Color fundus photograph; 2352x1568px.
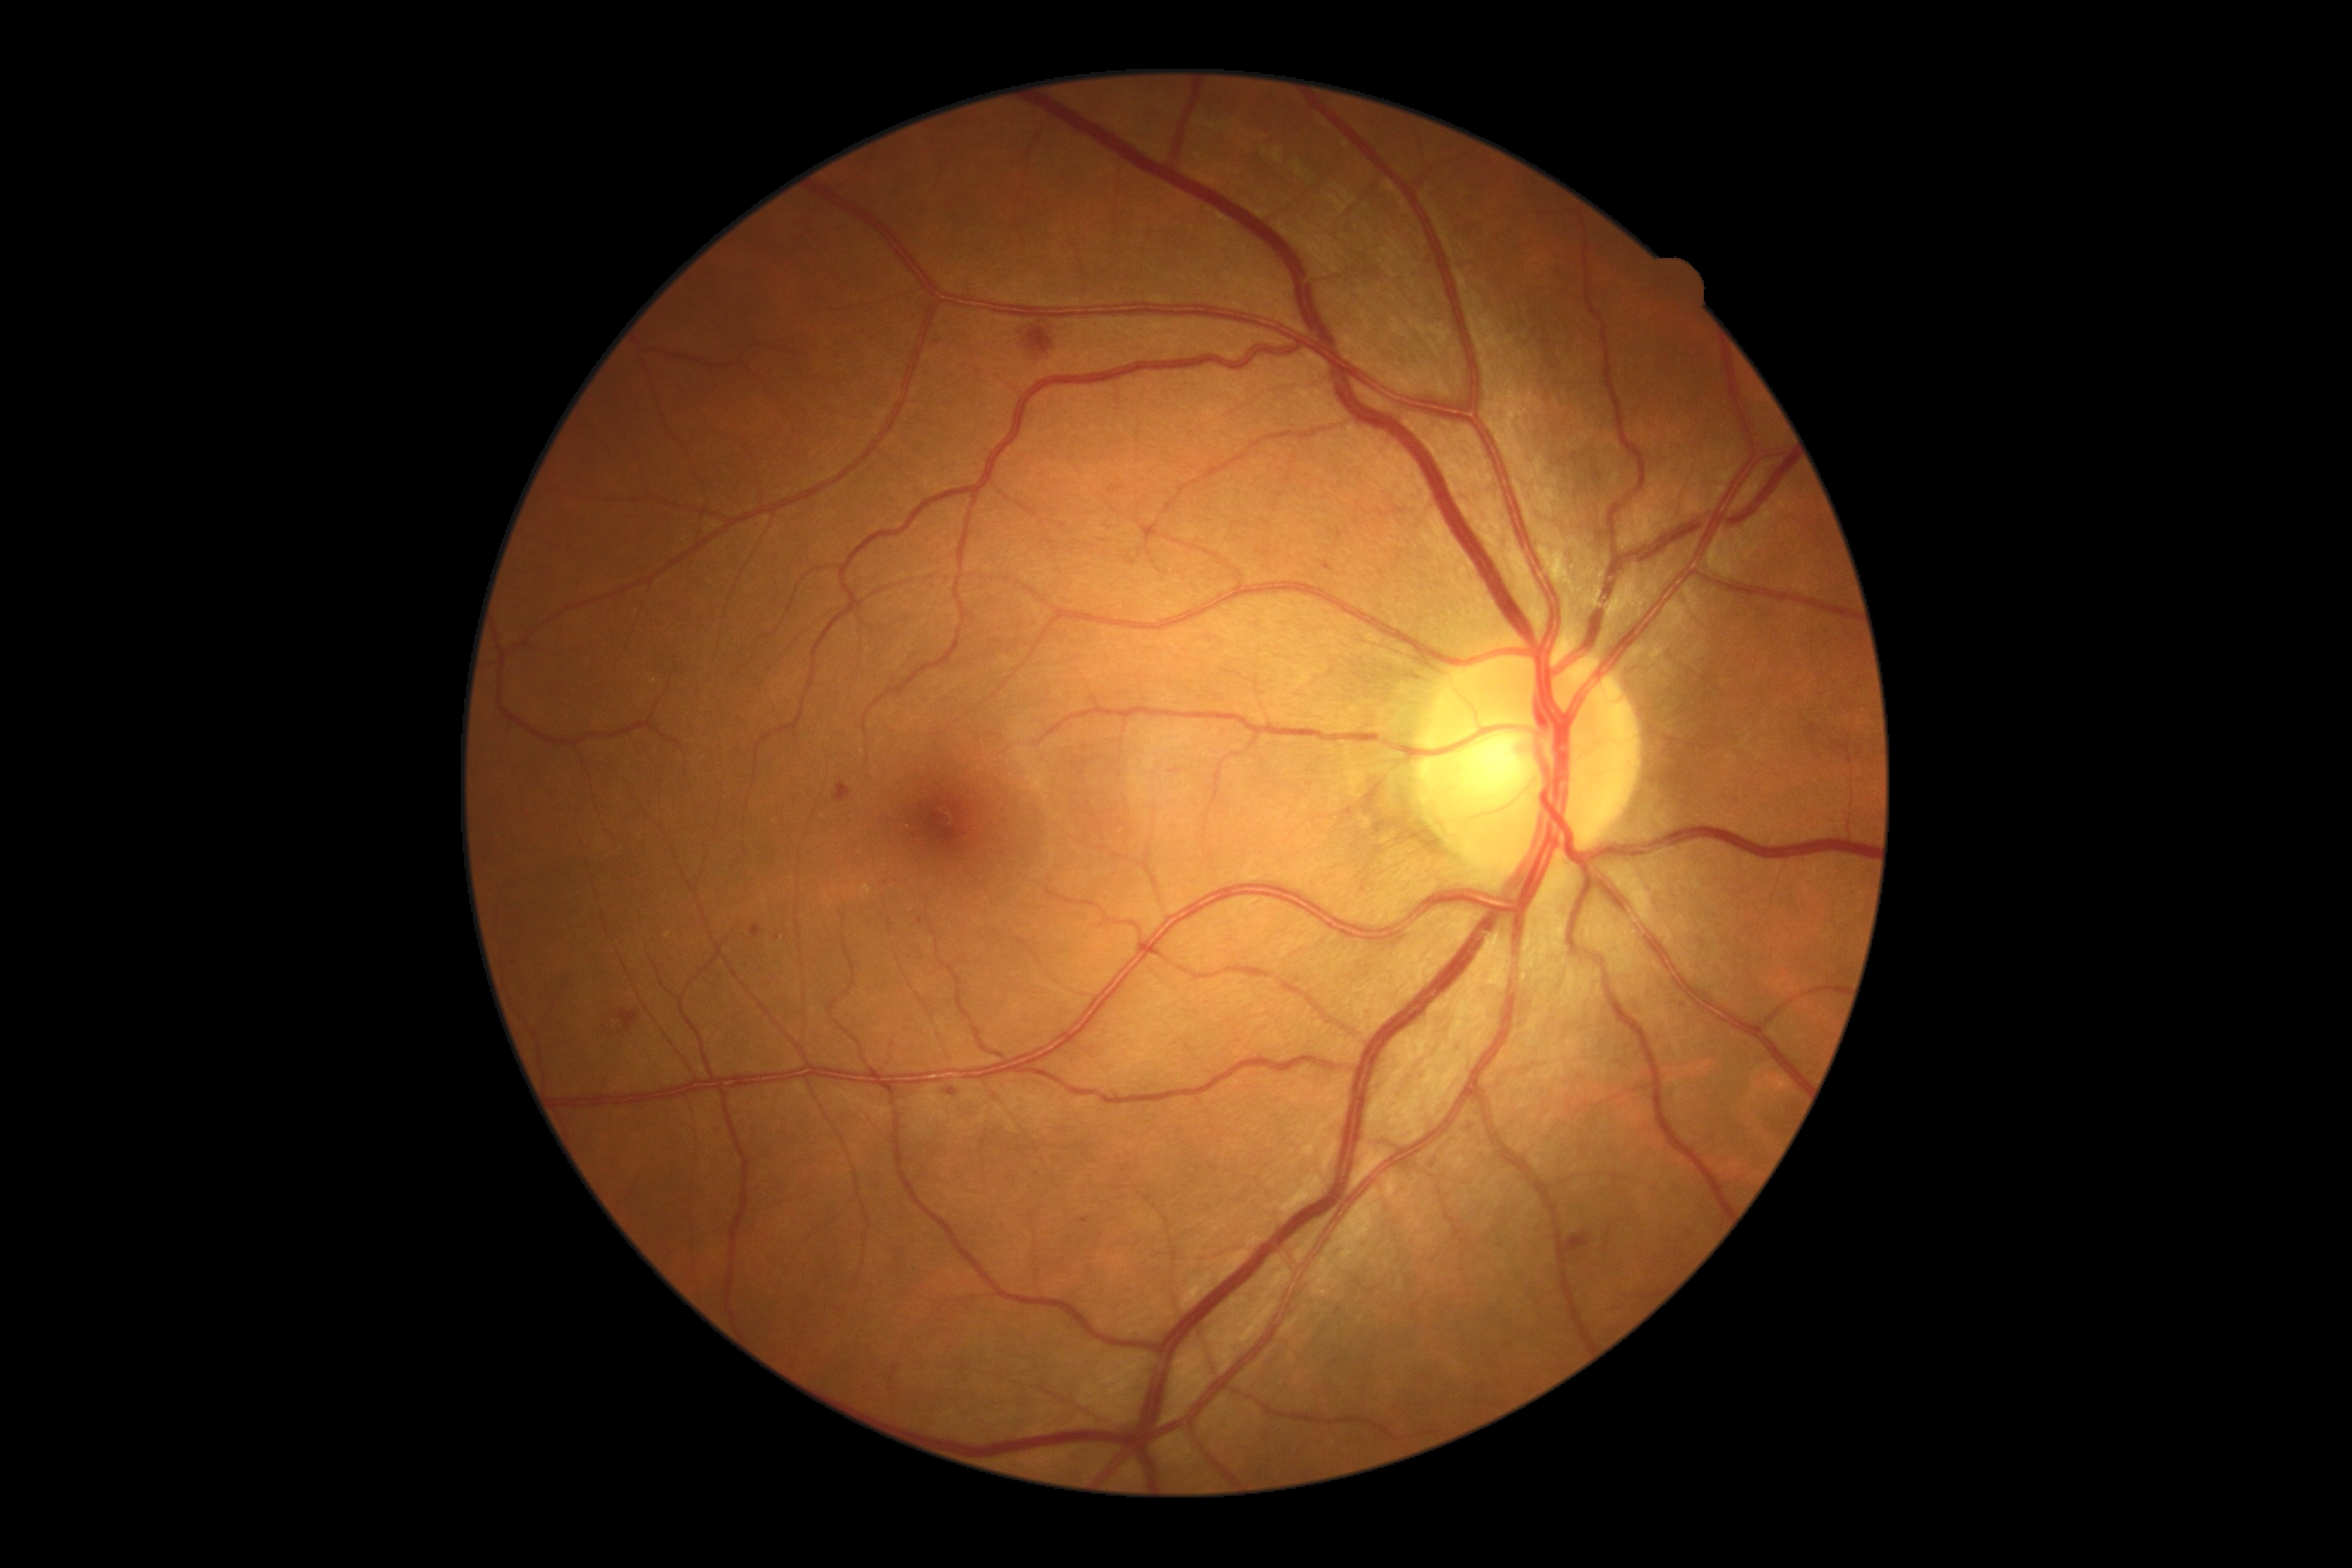

DR severity is 2.